Color fundus image: 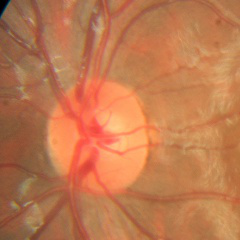 Glaucoma diagnosis = no glaucomatous changes.